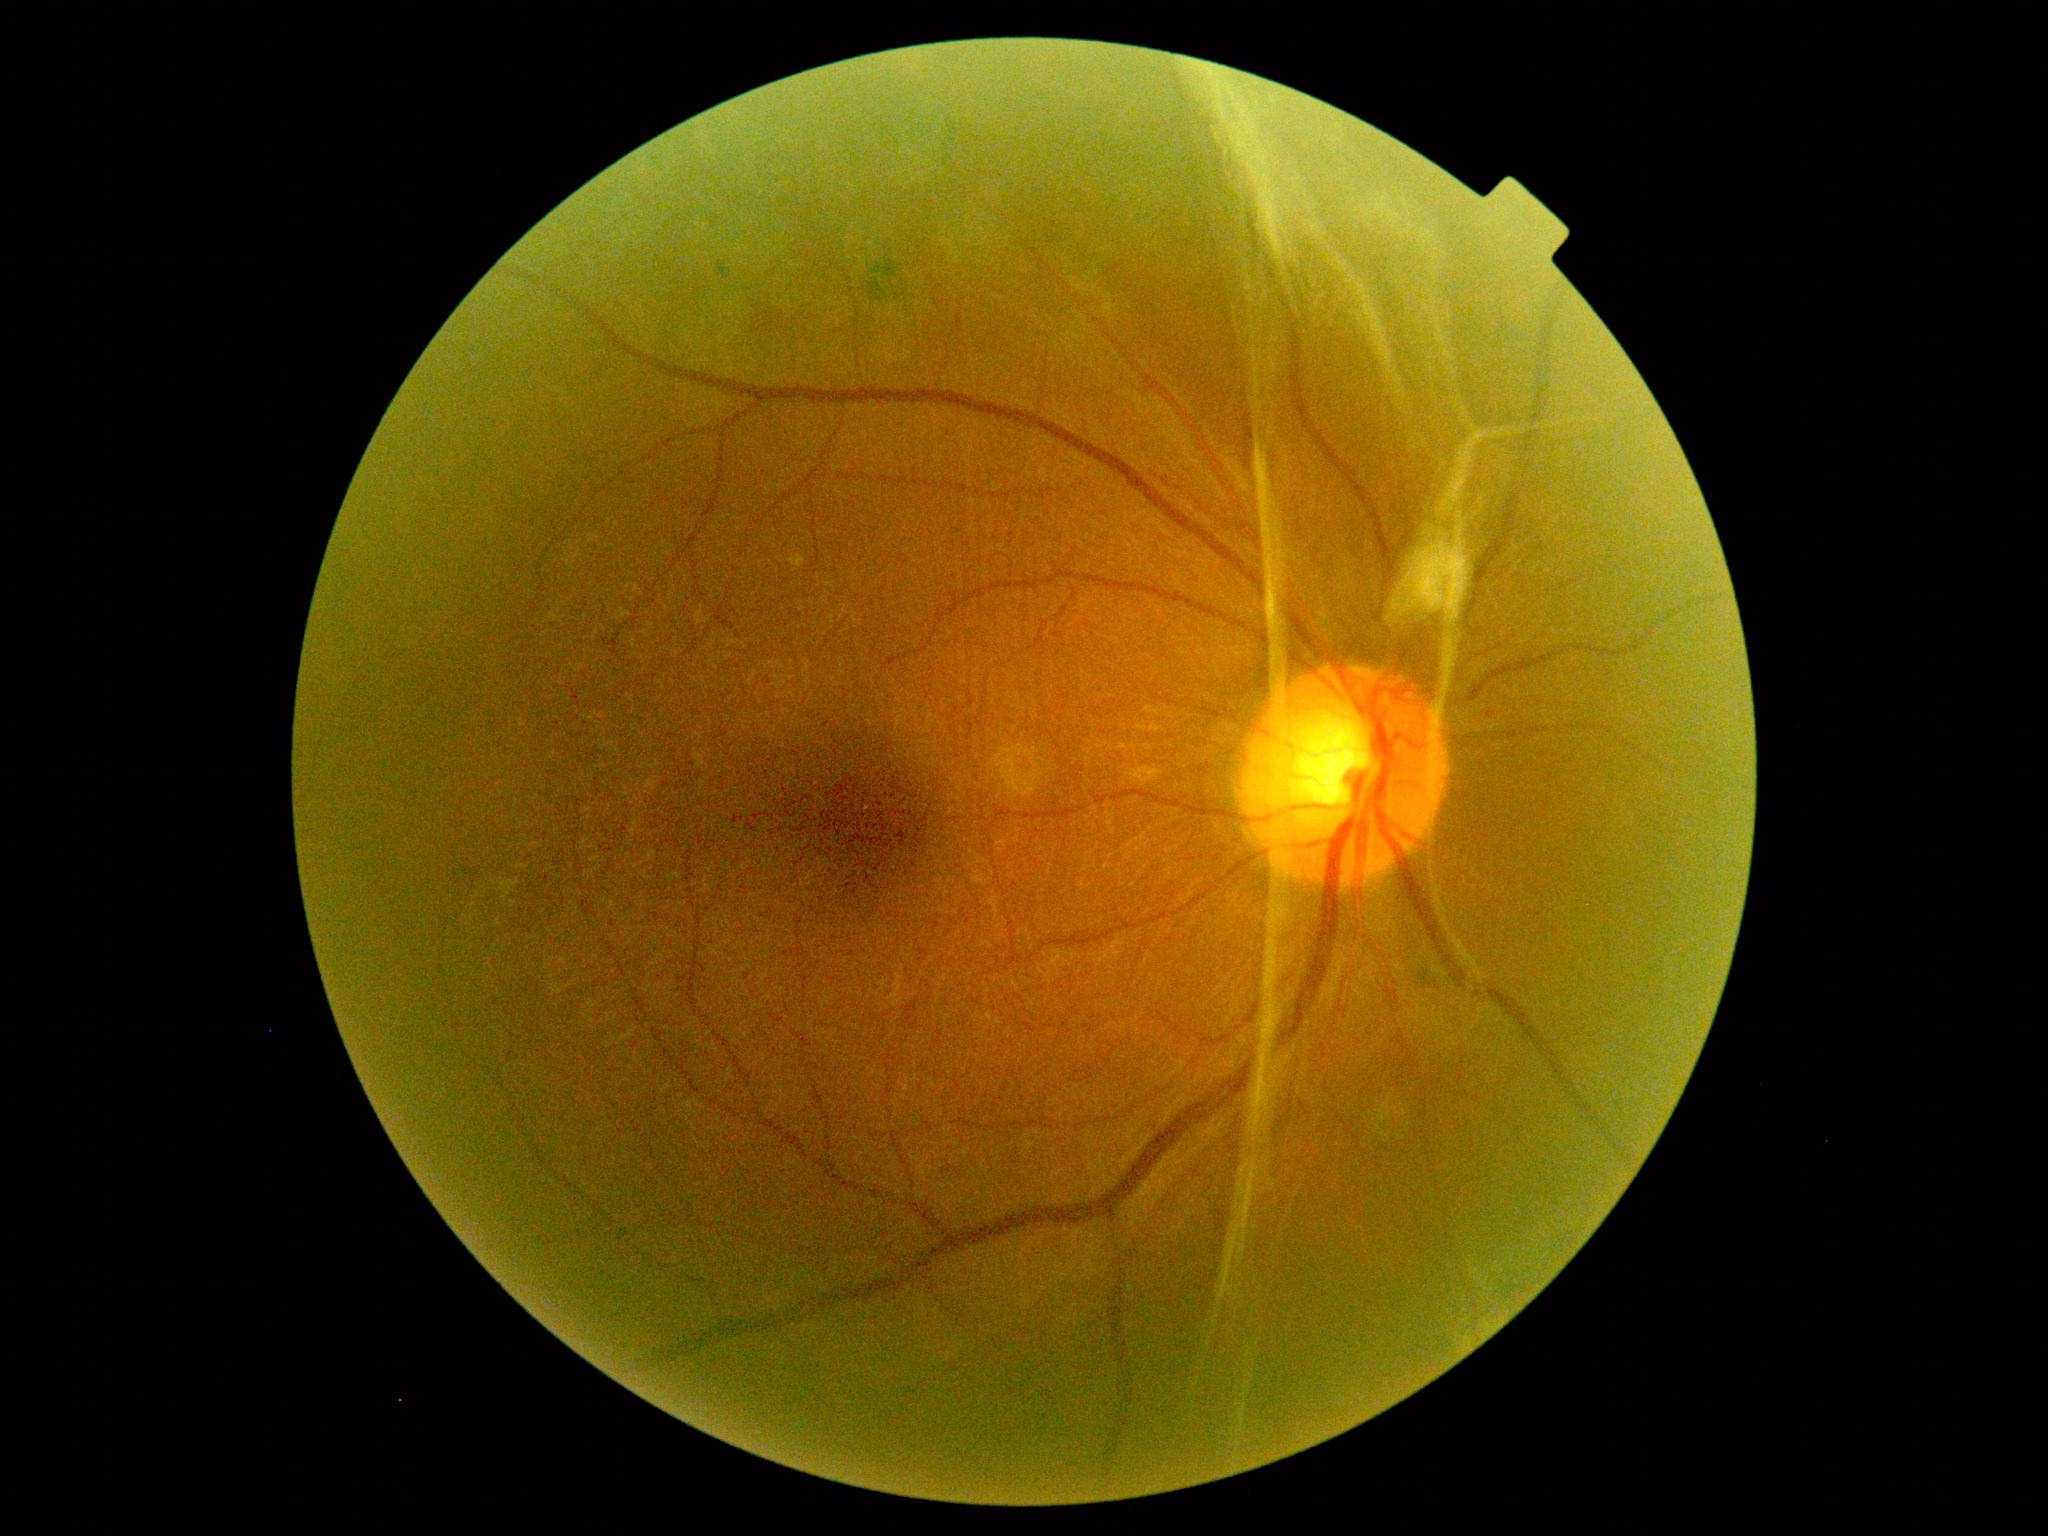 * diabetic retinopathy (DR) — grade 4